45-degree field of view; 1932 by 1932 pixels:
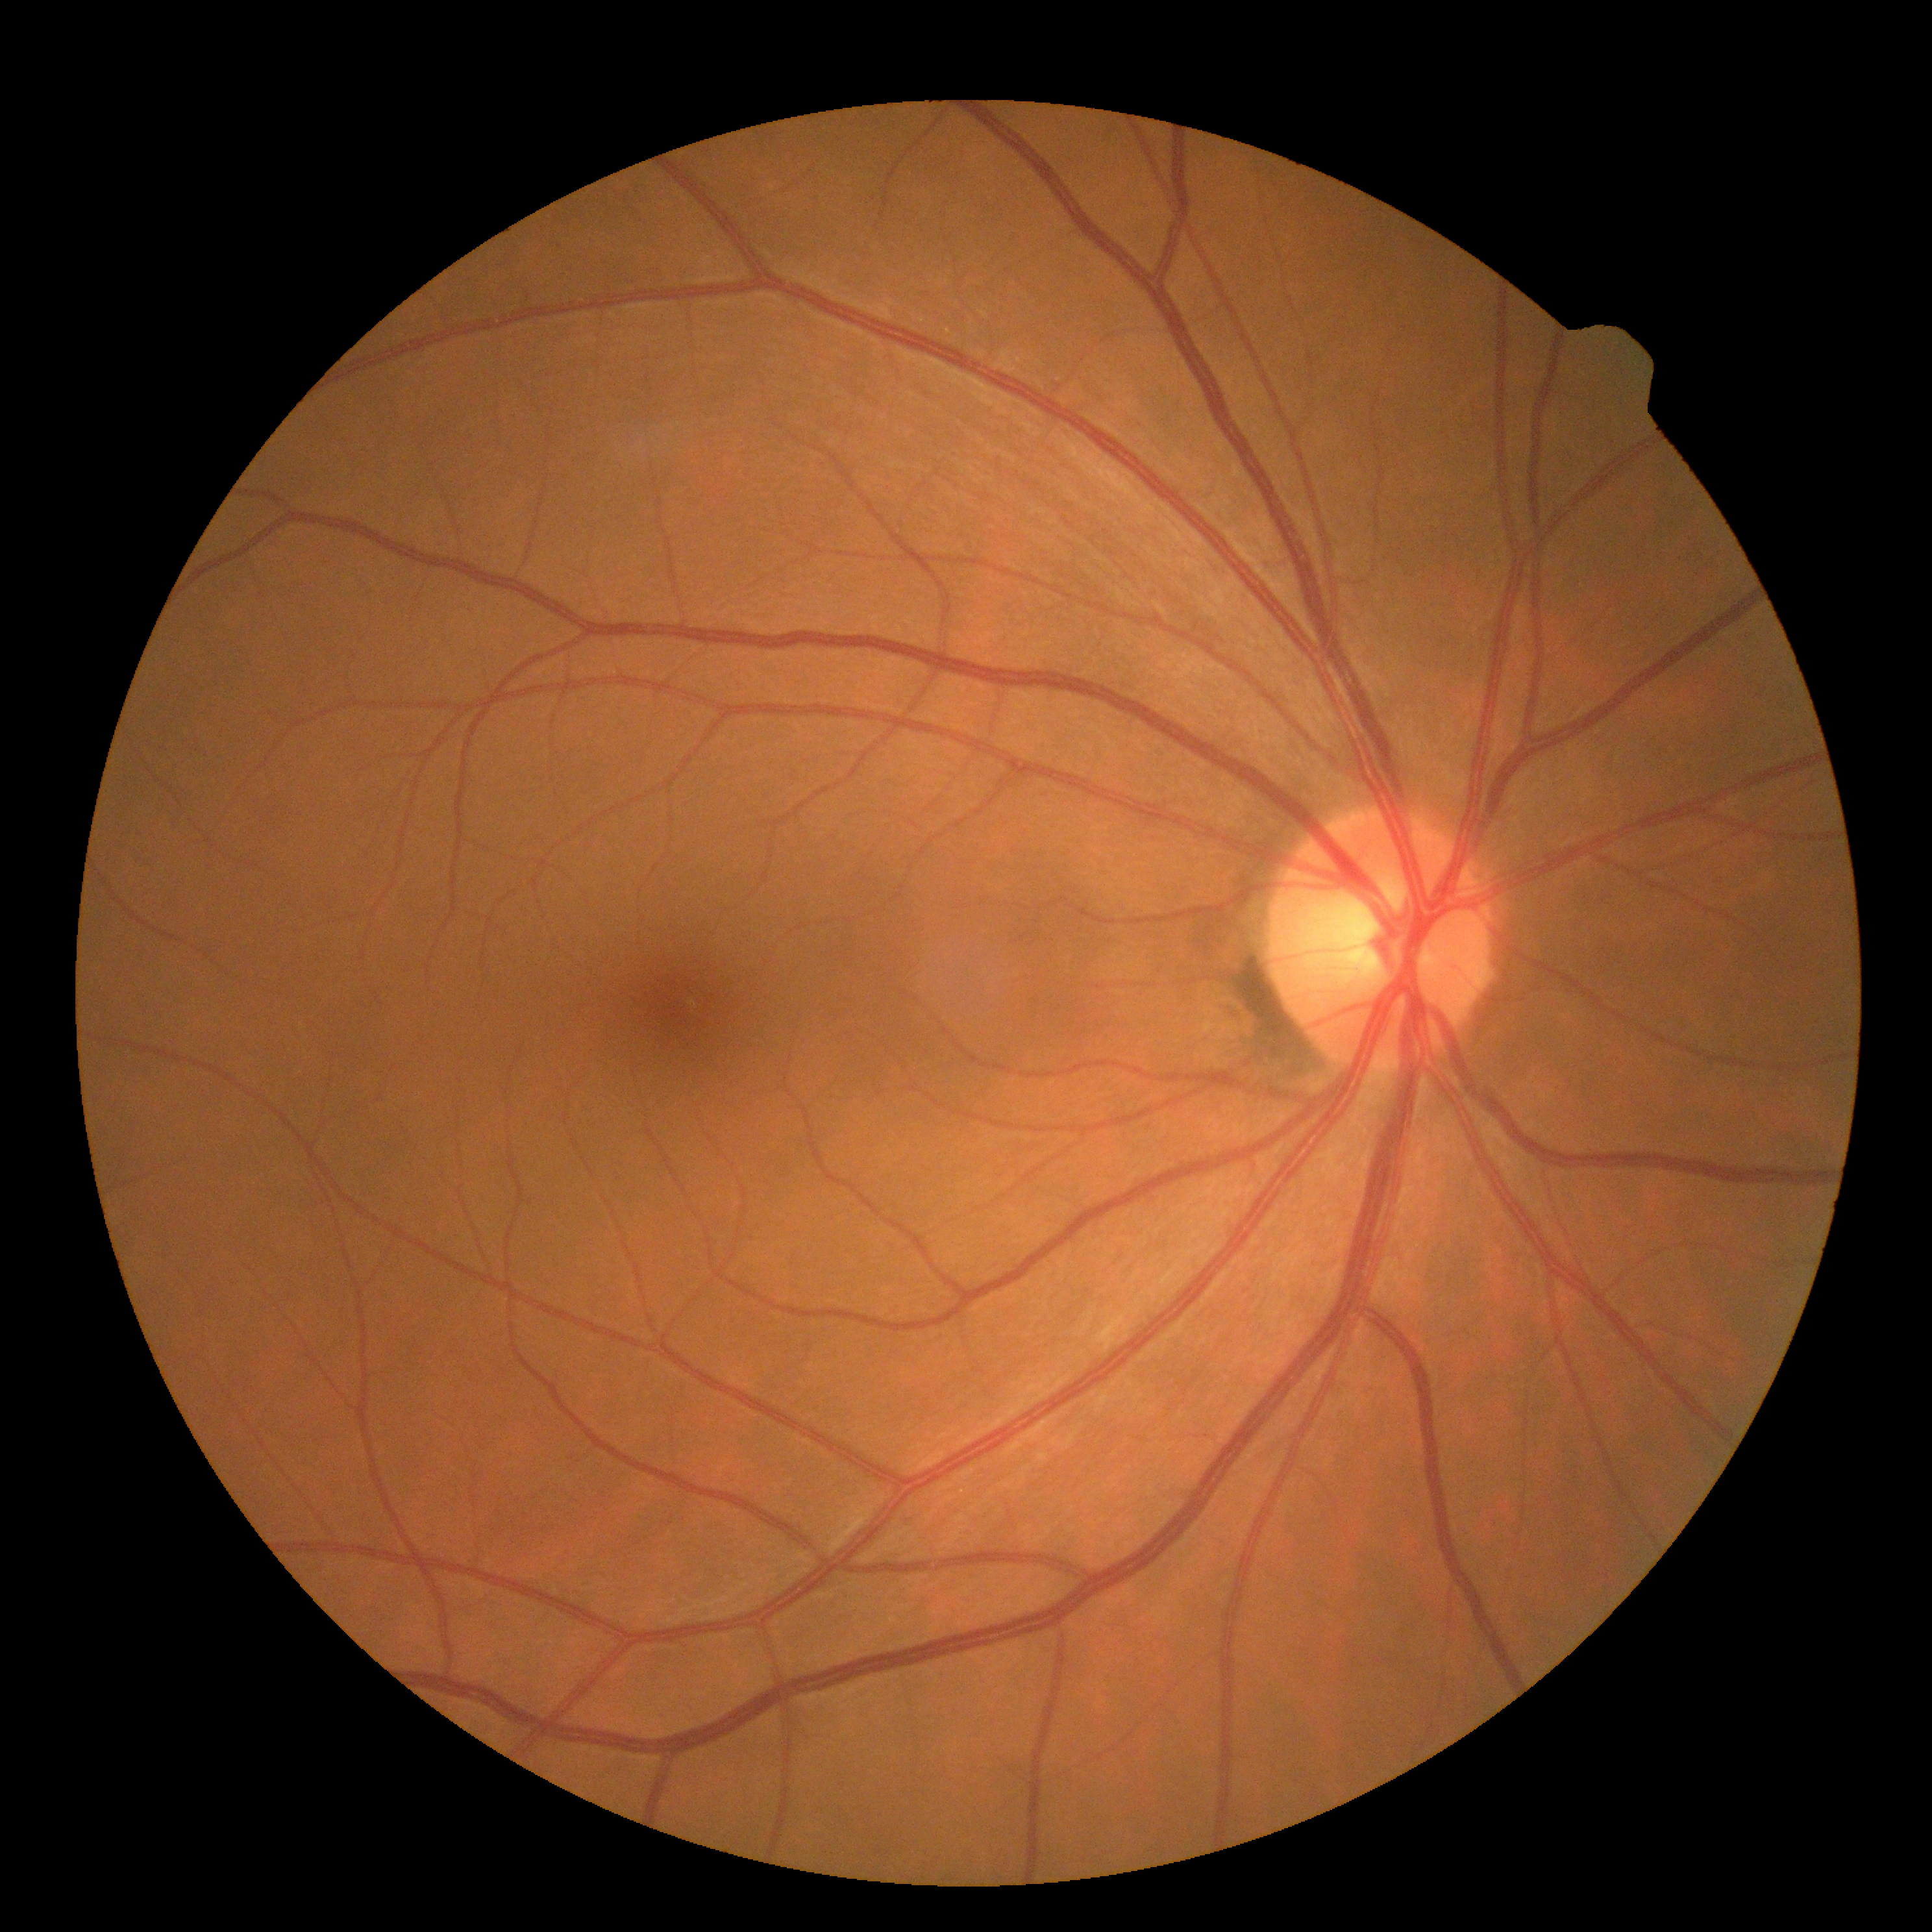
Diabetic retinopathy: 0/4.